Graded on the modified Davis scale; color fundus photograph
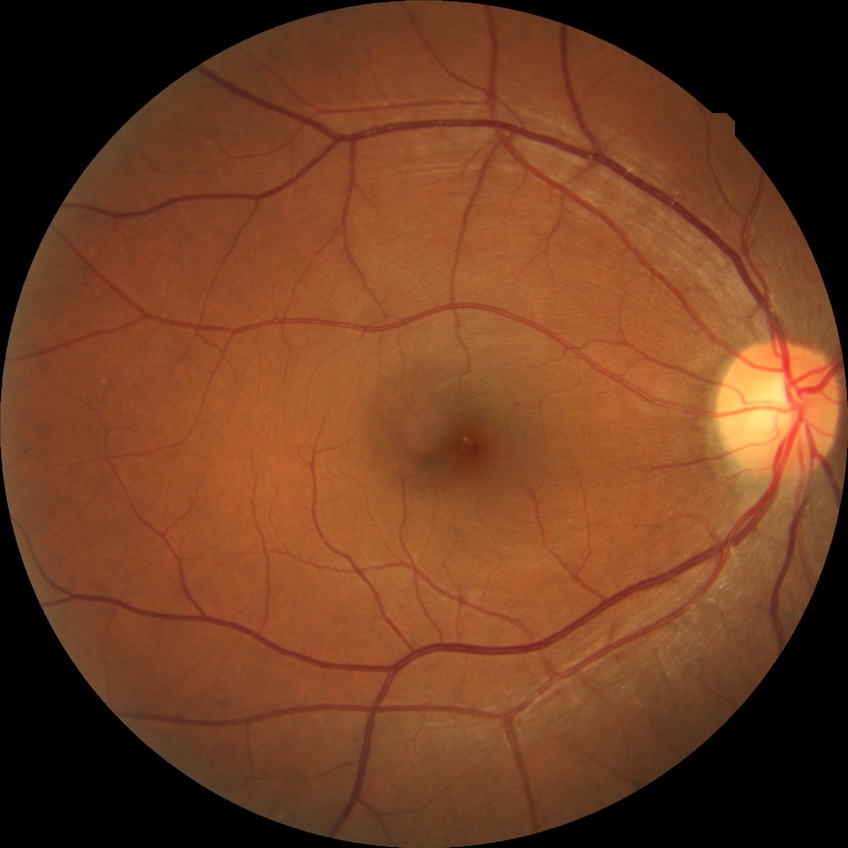
Modified Davis grade: NDR.